Non-mydriatic fundus camera; color fundus image; 240x240px: 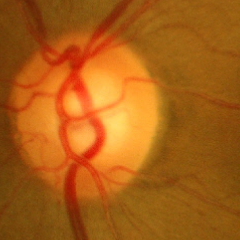

Impression = no glaucomatous optic neuropathy.